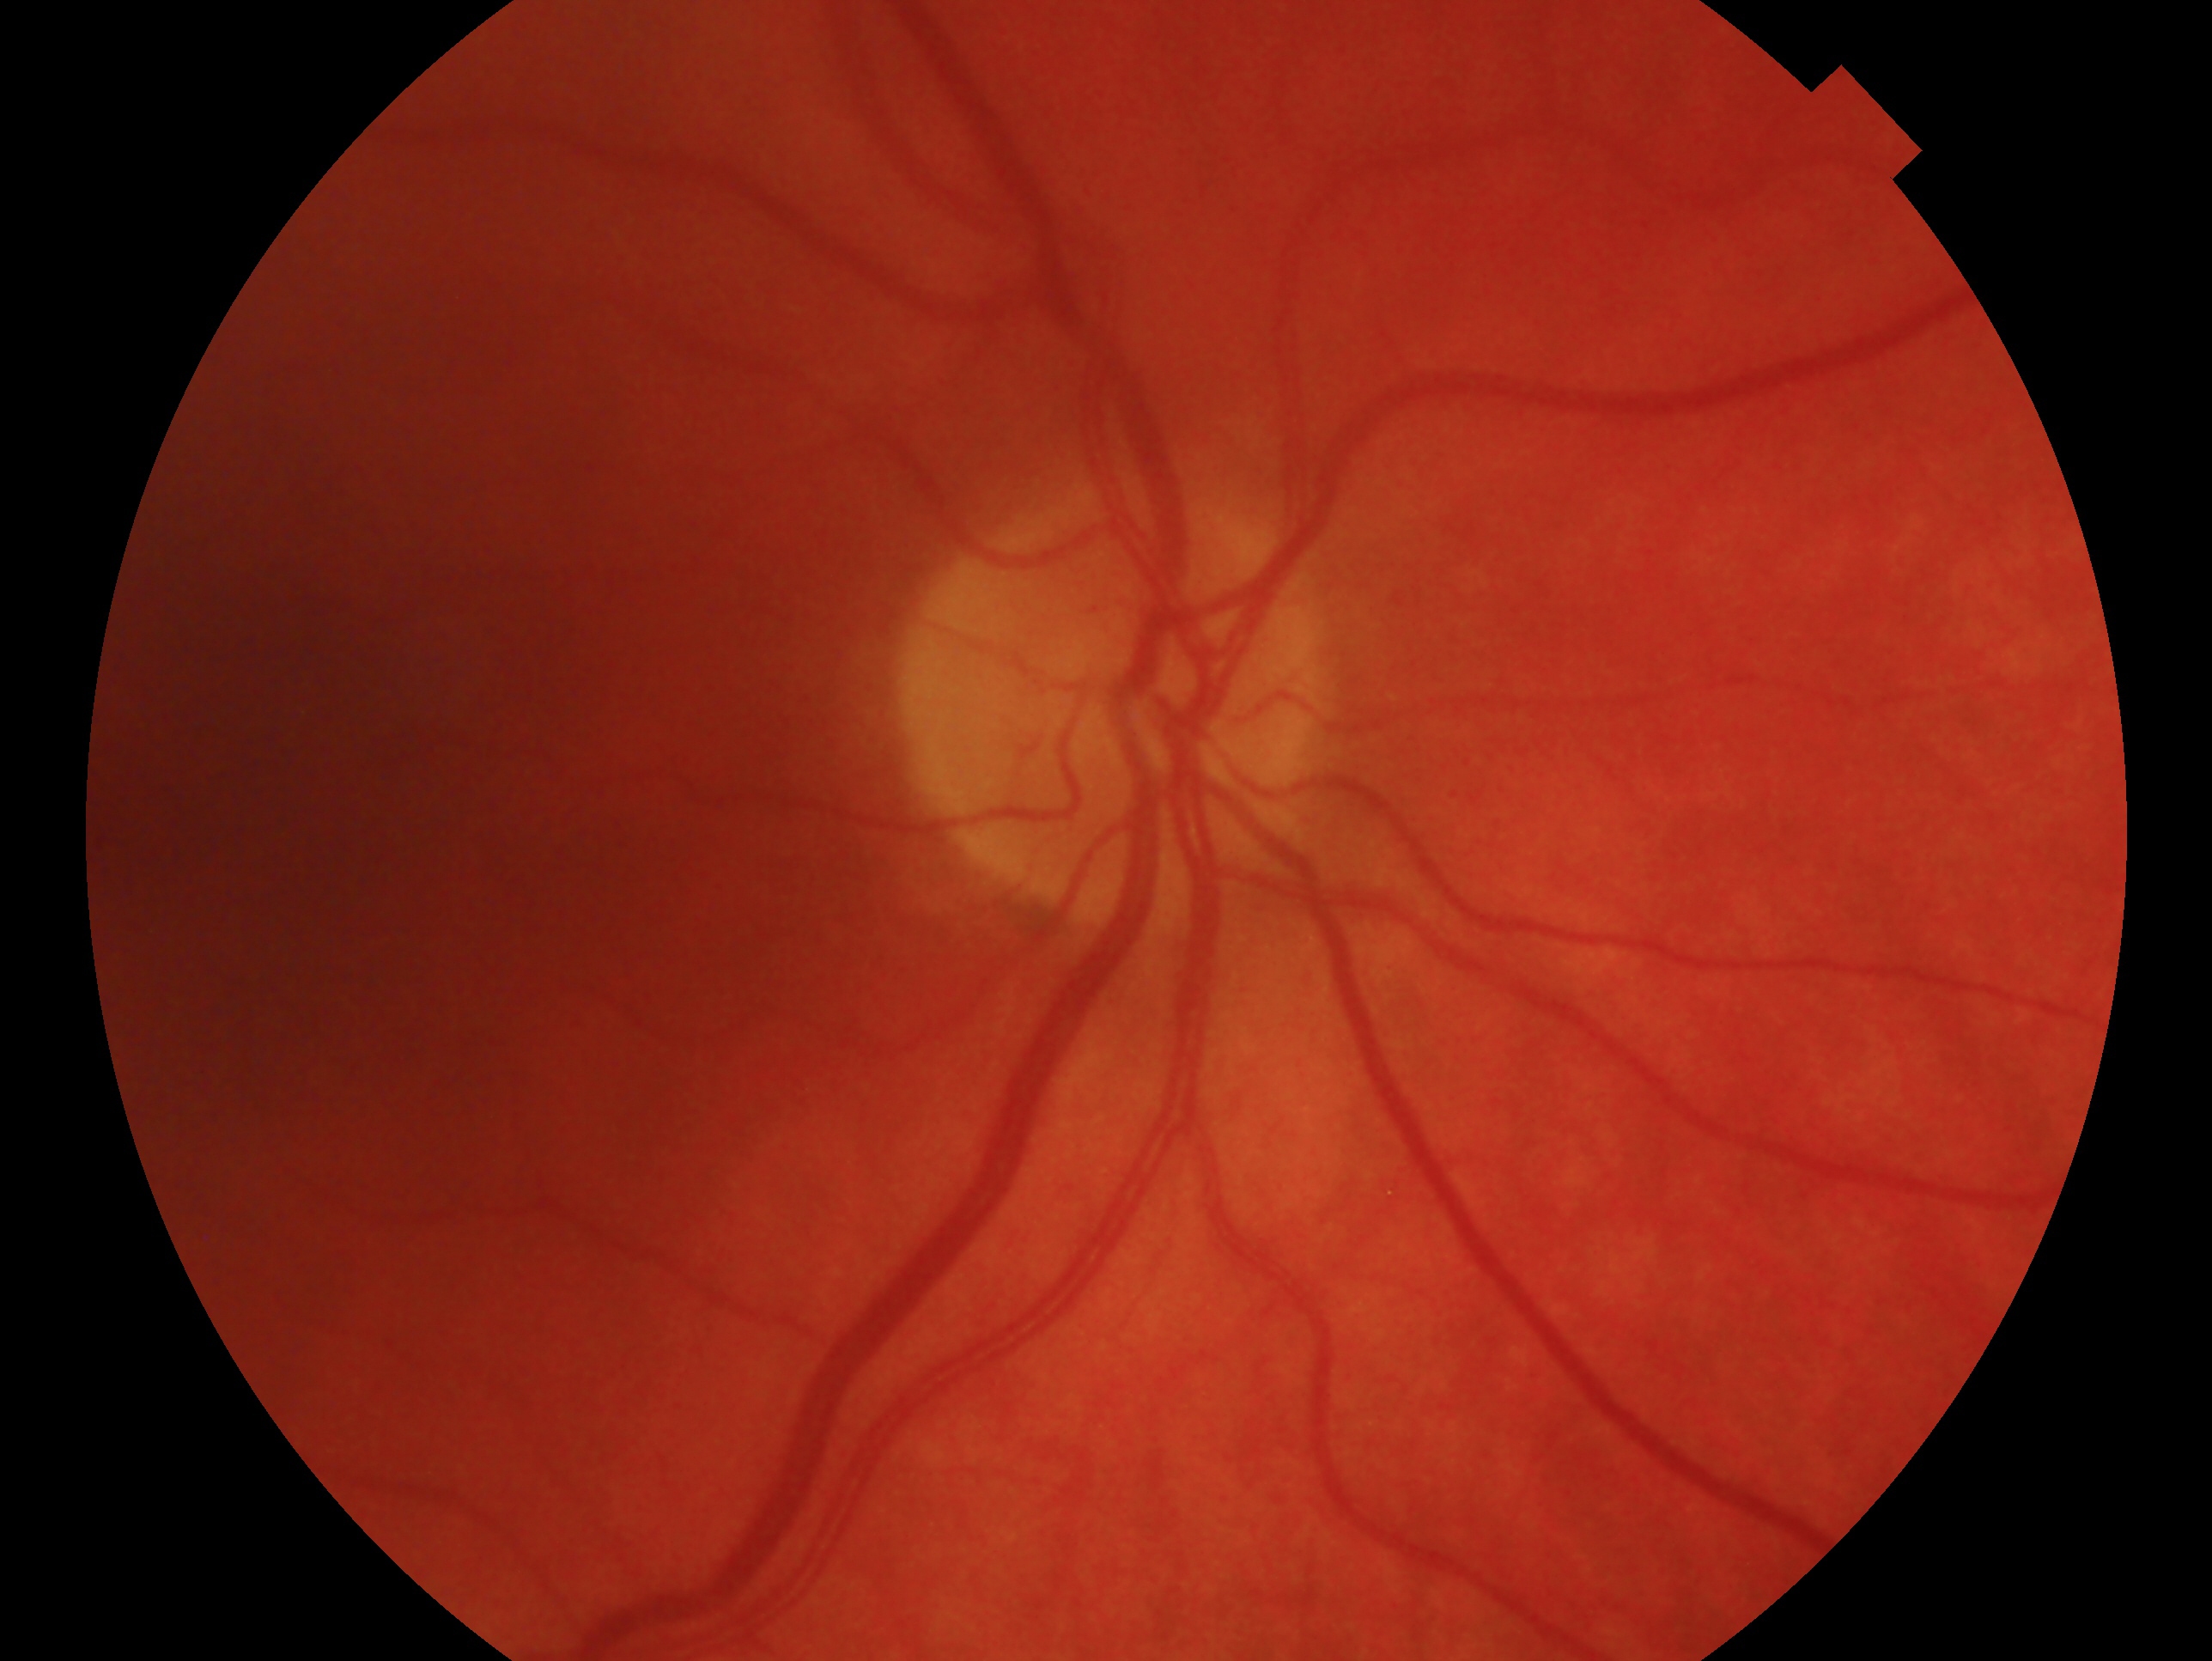
Glaucoma assessment — no evidence of glaucoma. The image shows the oculus dexter.